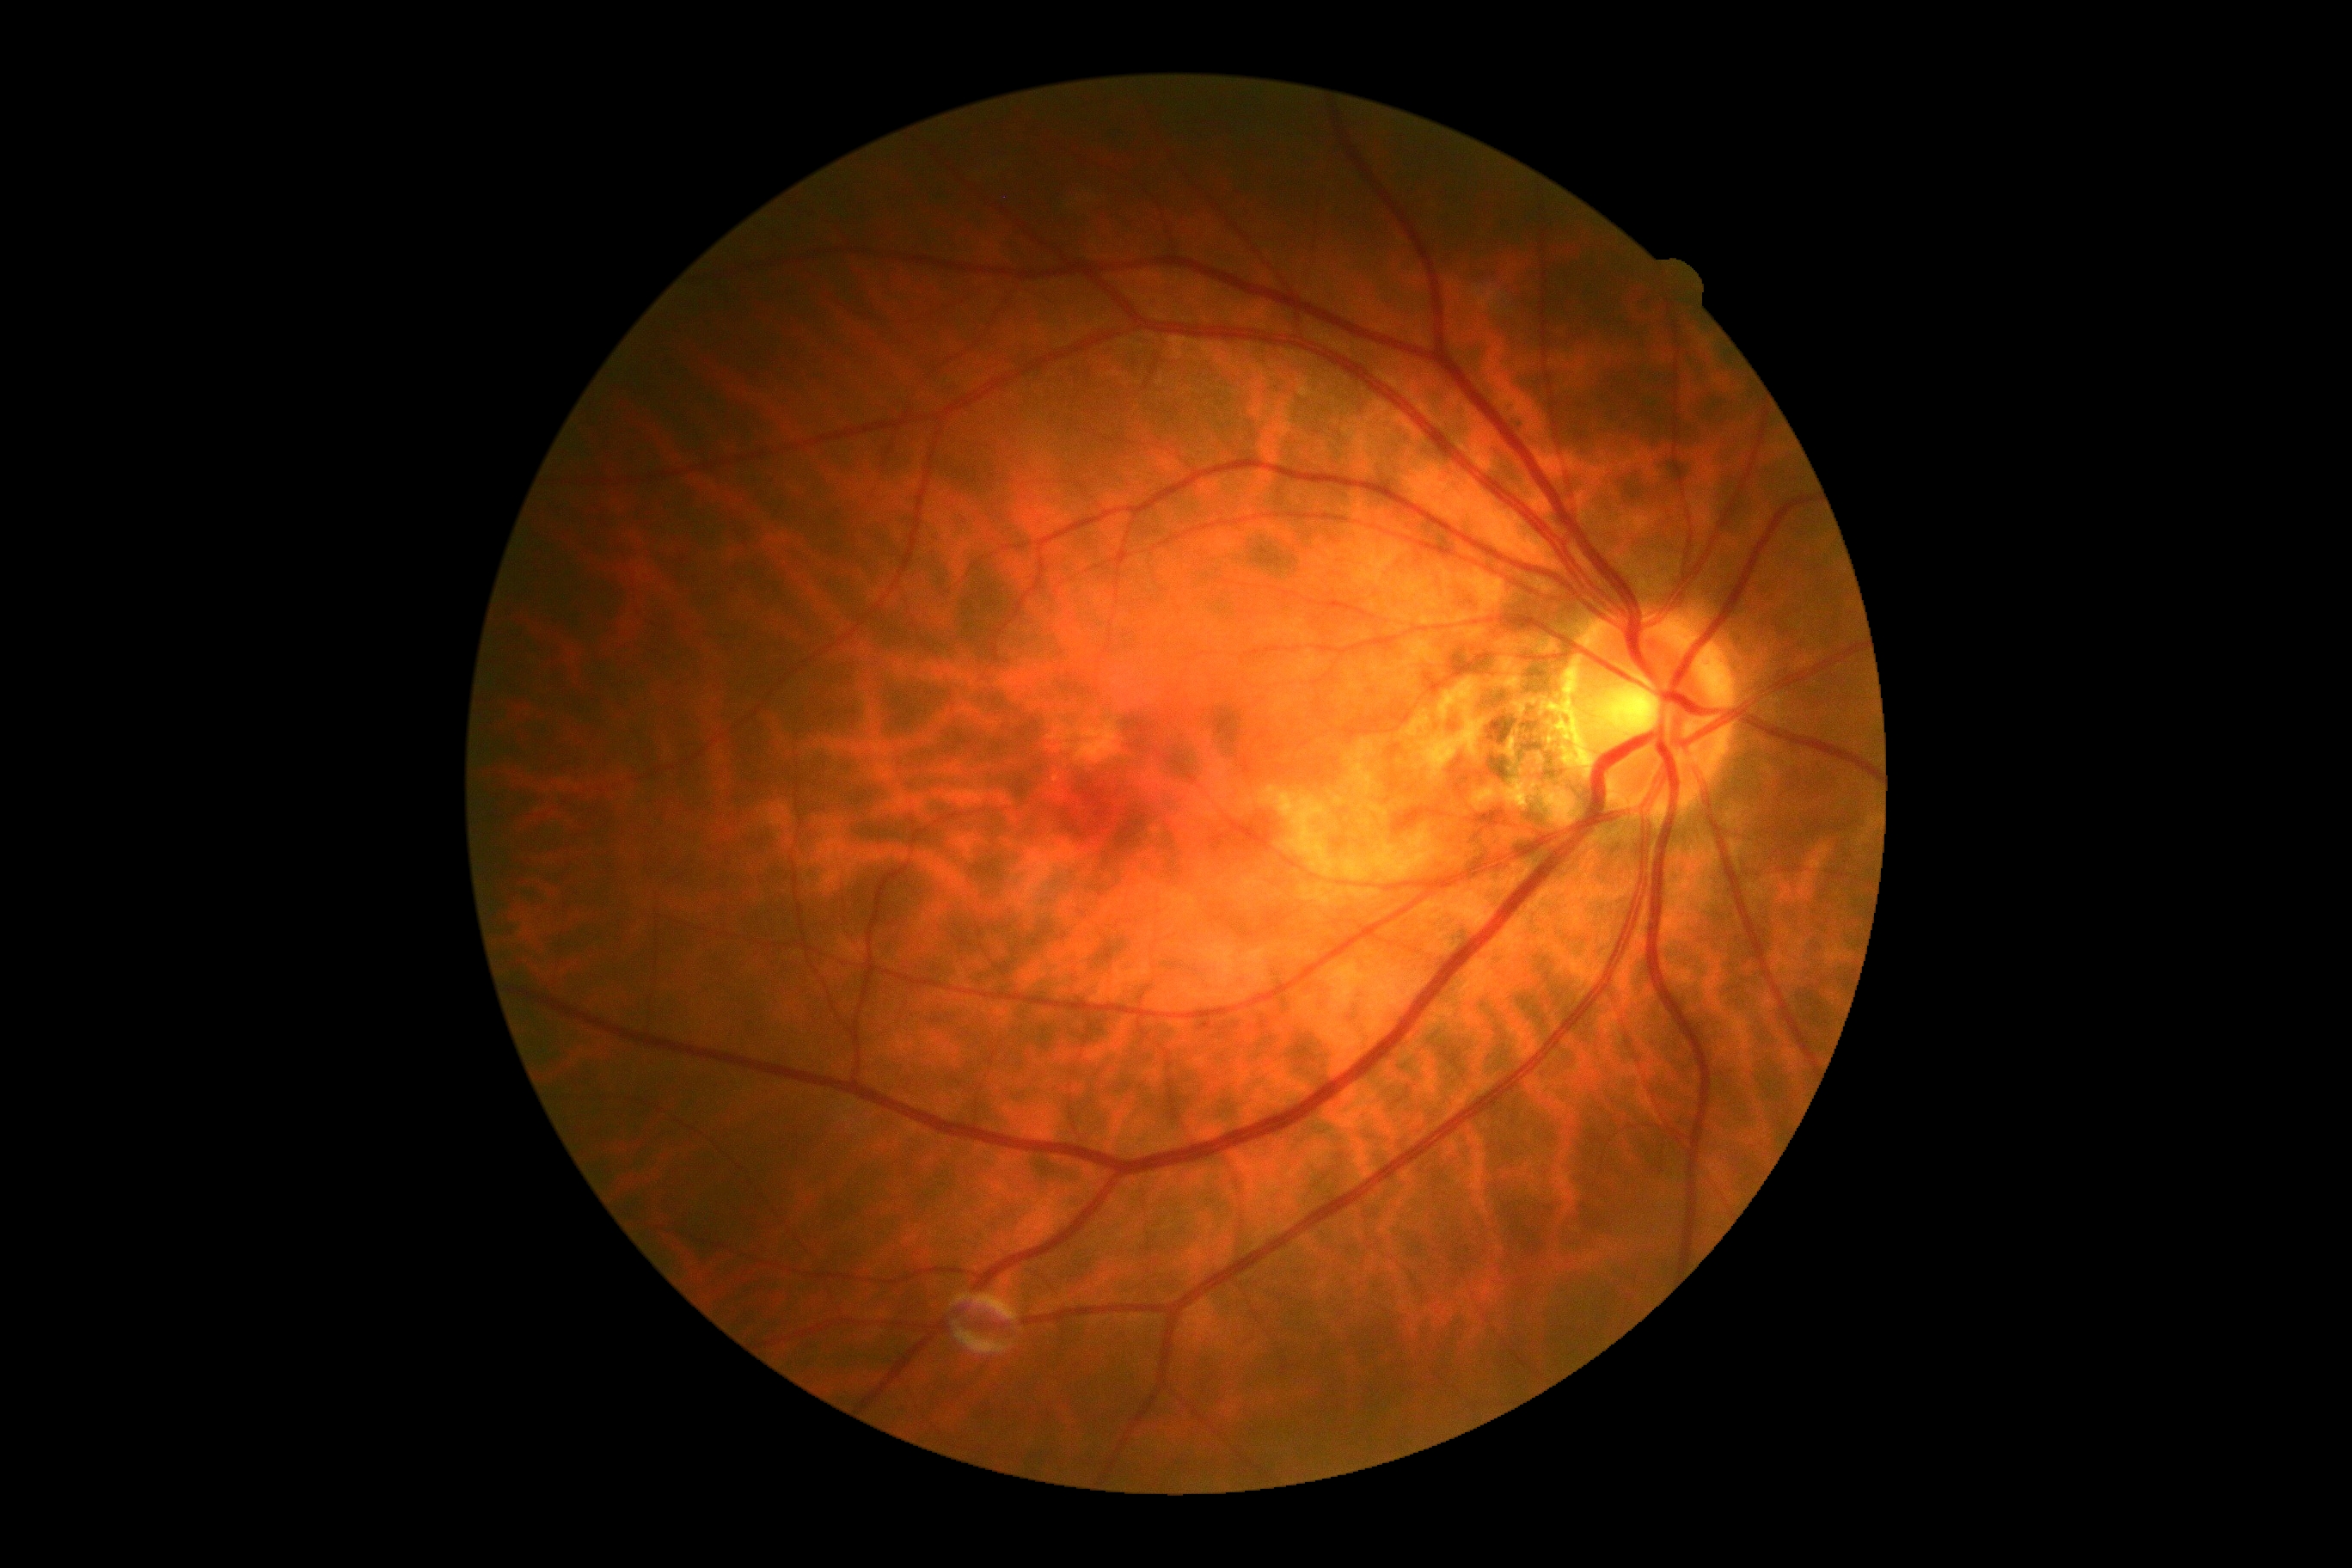
DR grade is 0/4.